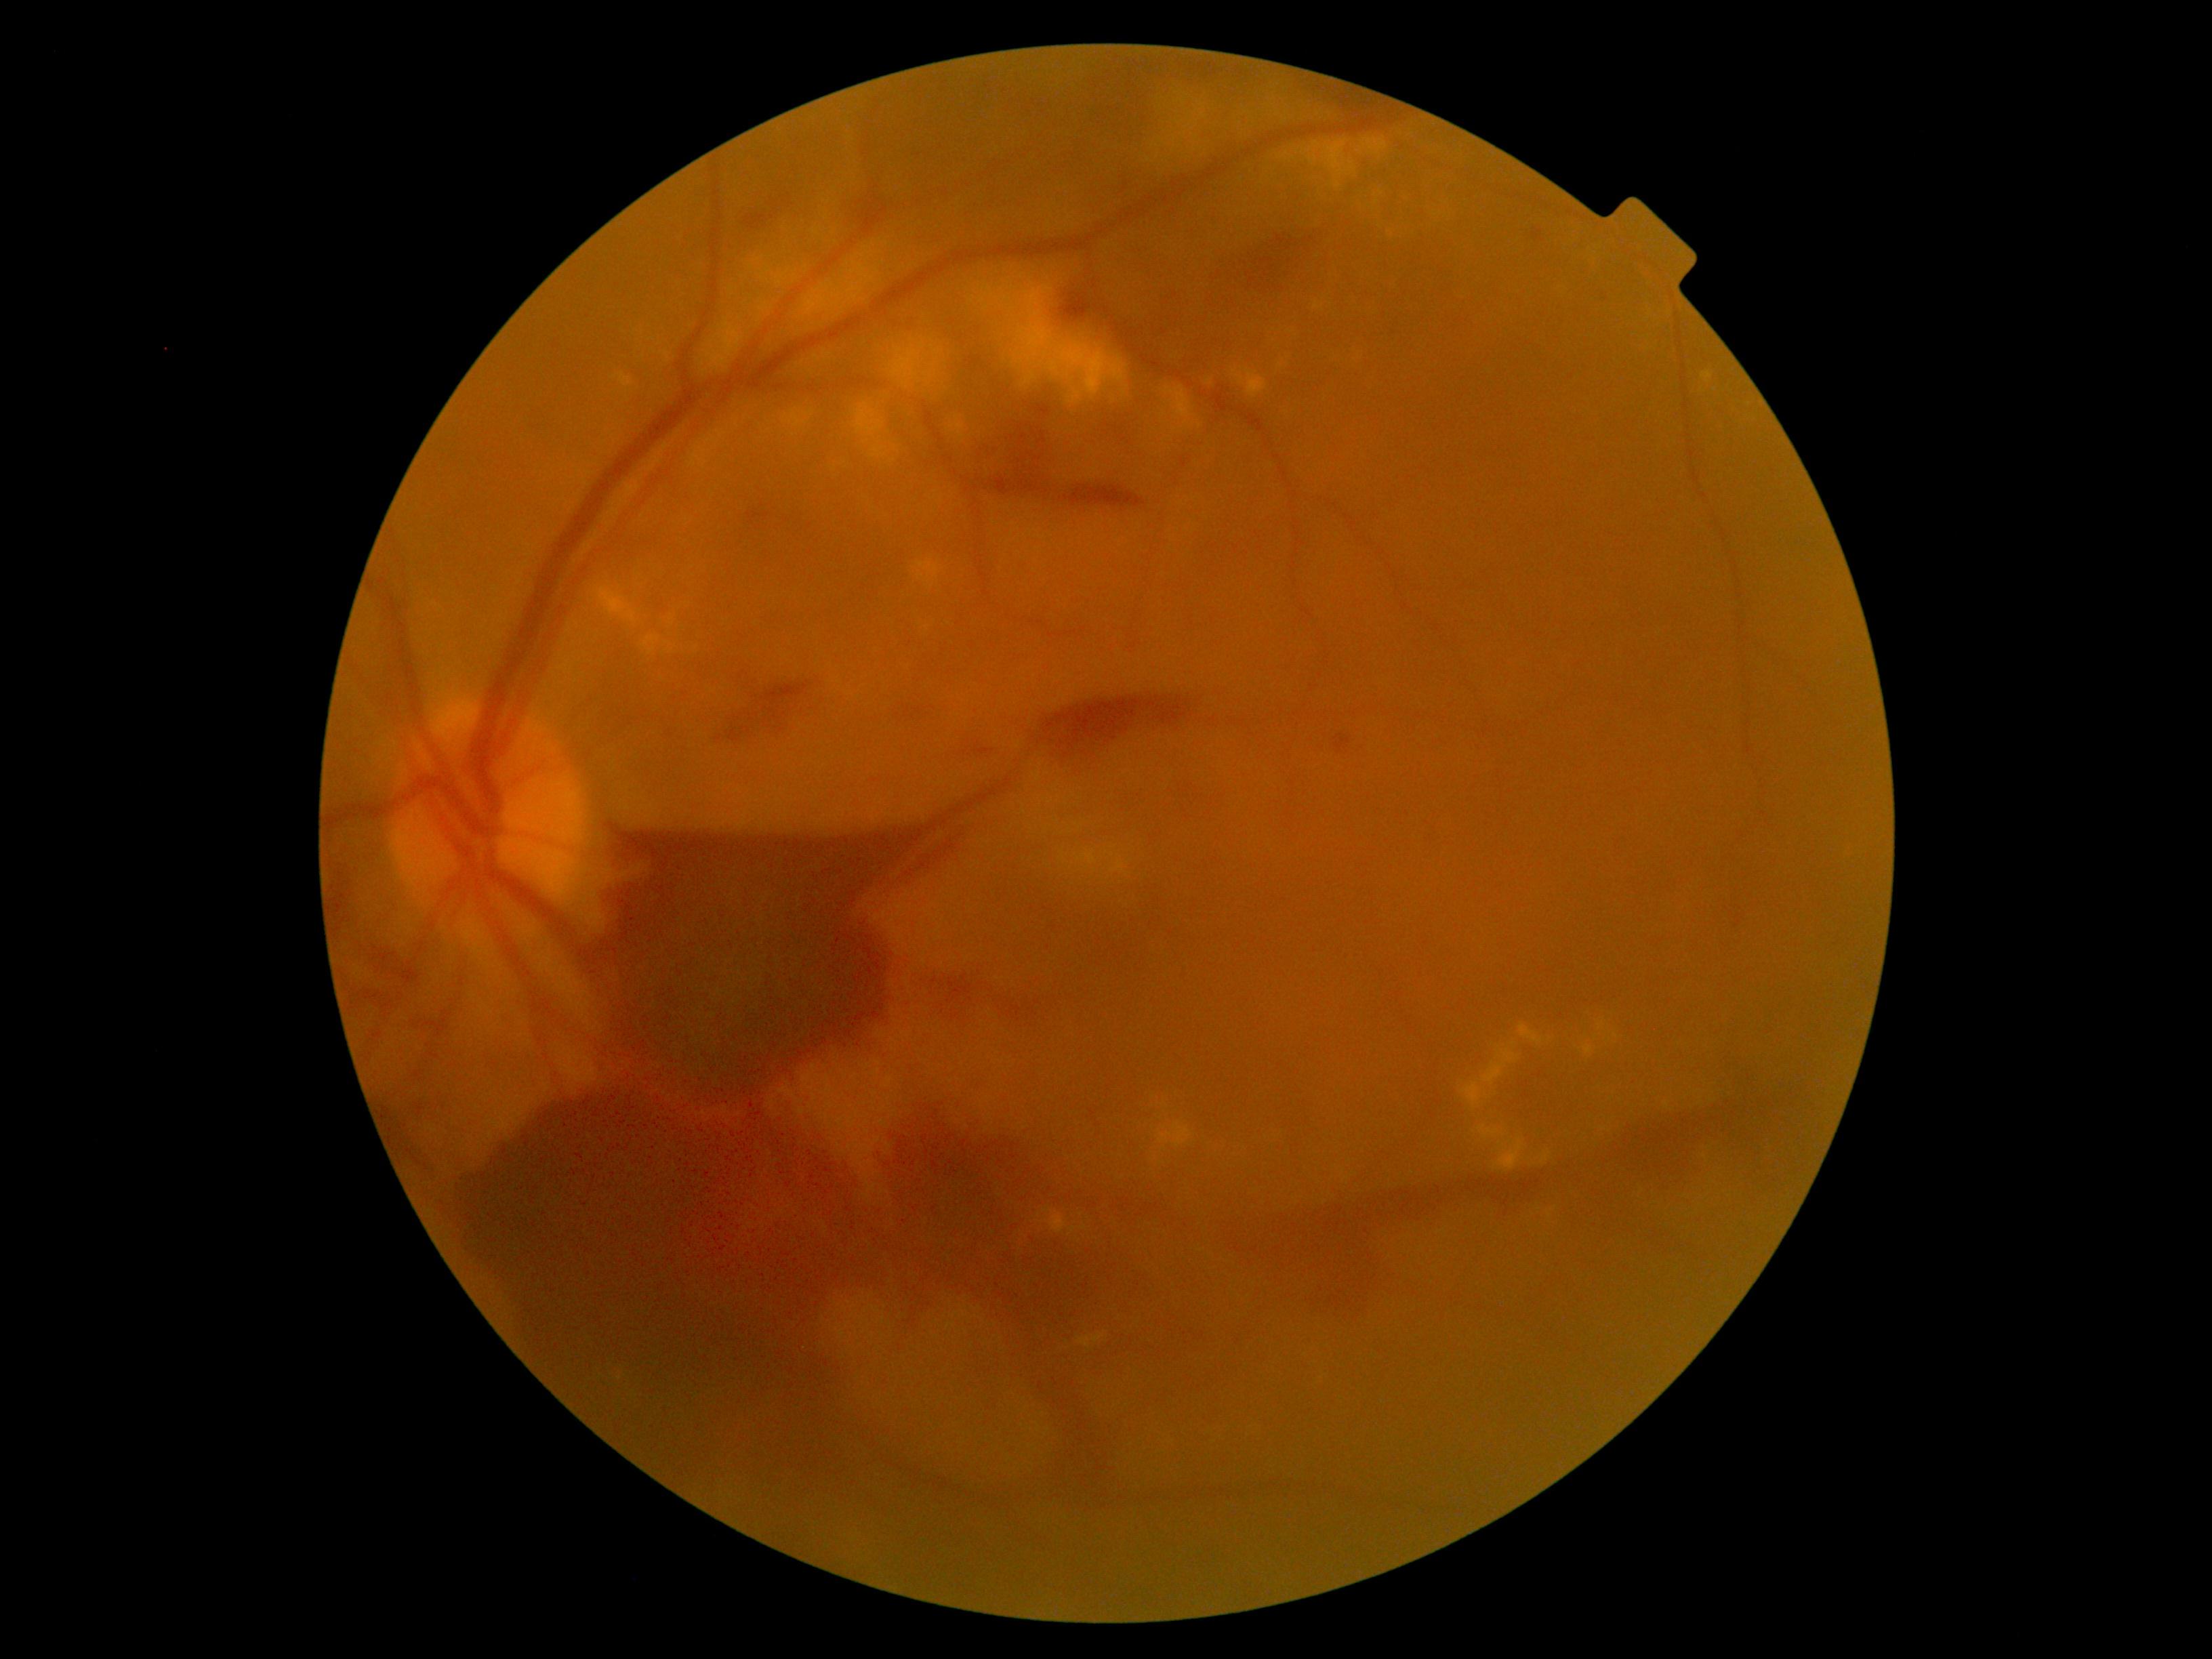
DR: 4/4
Lesions identified (partial list):
* EXs (more not shown): (left=1246, top=371, right=1268, bottom=398) | (left=783, top=410, right=807, bottom=428) | (left=1208, top=1136, right=1230, bottom=1151) | (left=1401, top=190, right=1416, bottom=201) | (left=1540, top=1151, right=1549, bottom=1164) | (left=1582, top=1046, right=1593, bottom=1054) | (left=1149, top=1094, right=1169, bottom=1107) | (left=670, top=617, right=673, bottom=627) | (left=1155, top=98, right=1212, bottom=155) | (left=643, top=635, right=659, bottom=647) | (left=649, top=647, right=657, bottom=655) | (left=705, top=318, right=745, bottom=372) | (left=1494, top=1139, right=1524, bottom=1170)
* Small EXs approximately at (763; 277) | (876; 270) | (1347; 356) | (1604; 1129)